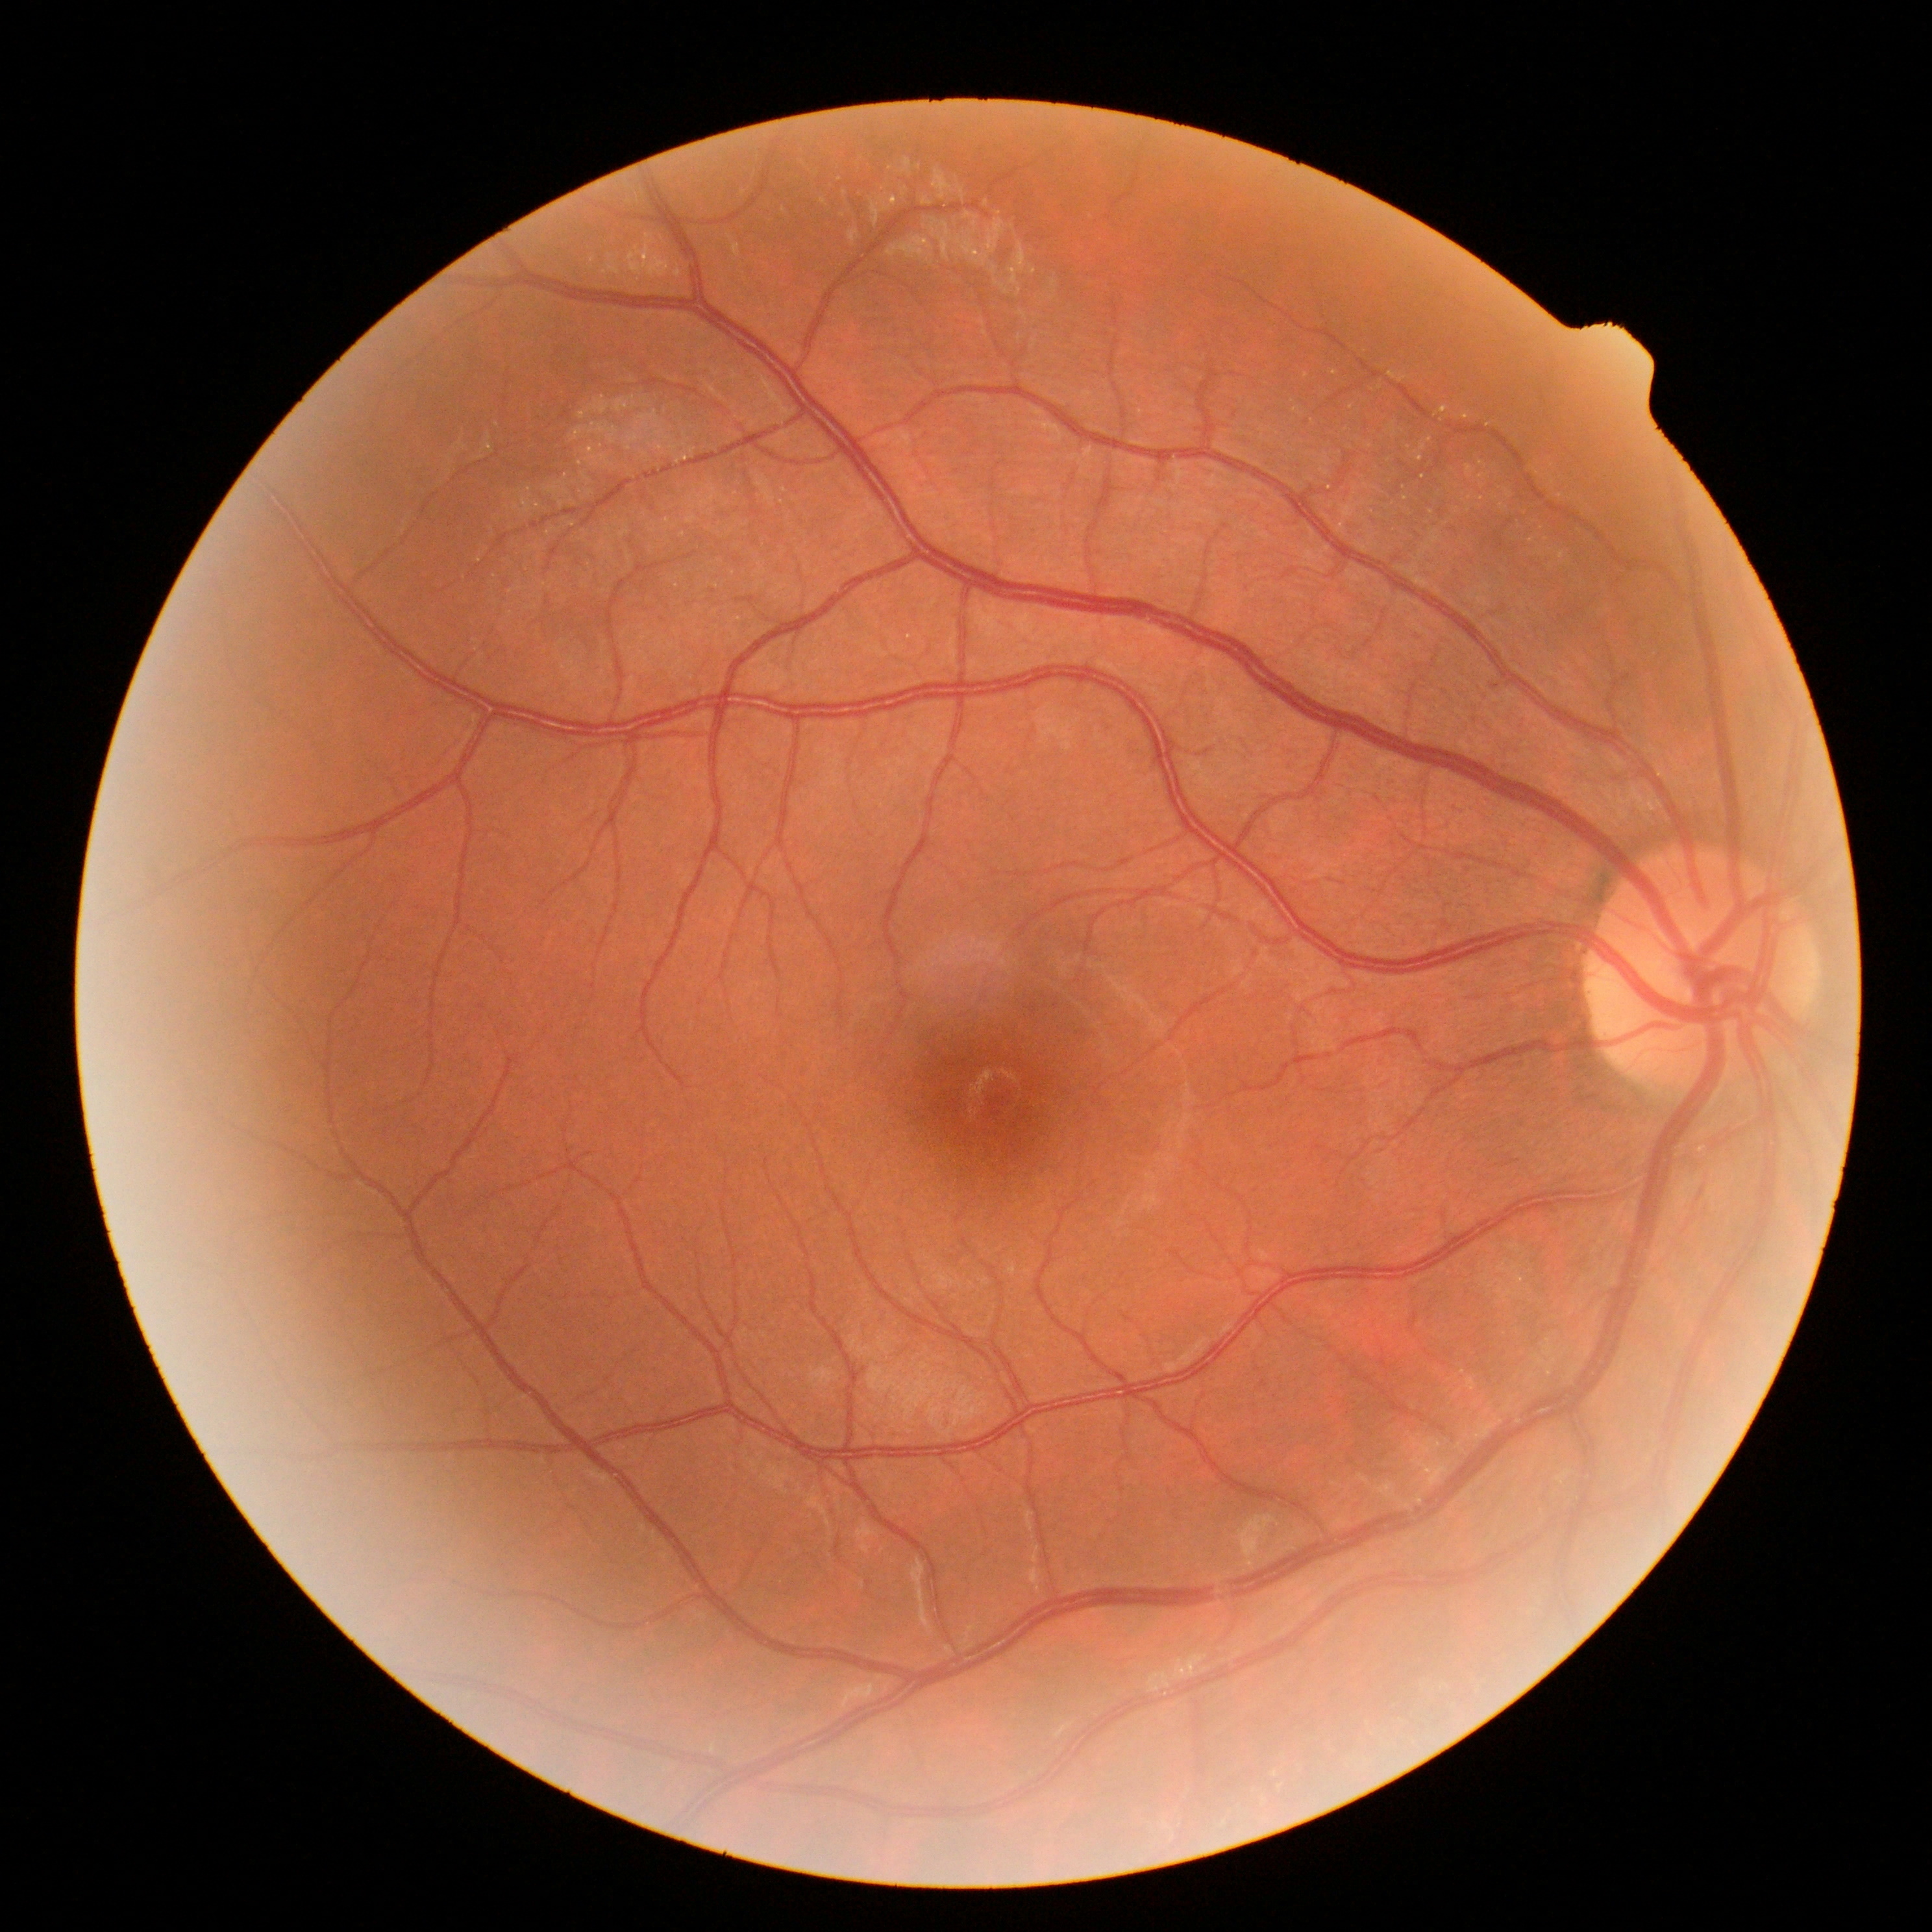

{
  "dr_grade": "0"
}